640 x 480 pixels · infant wide-field retinal image · 130° field of view (Clarity RetCam 3):
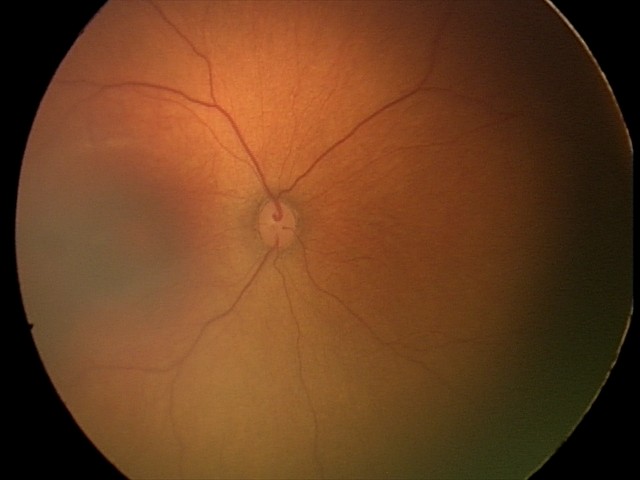
Examination with physiological retinal findings.